Retinal fundus photograph · 45° FOV — 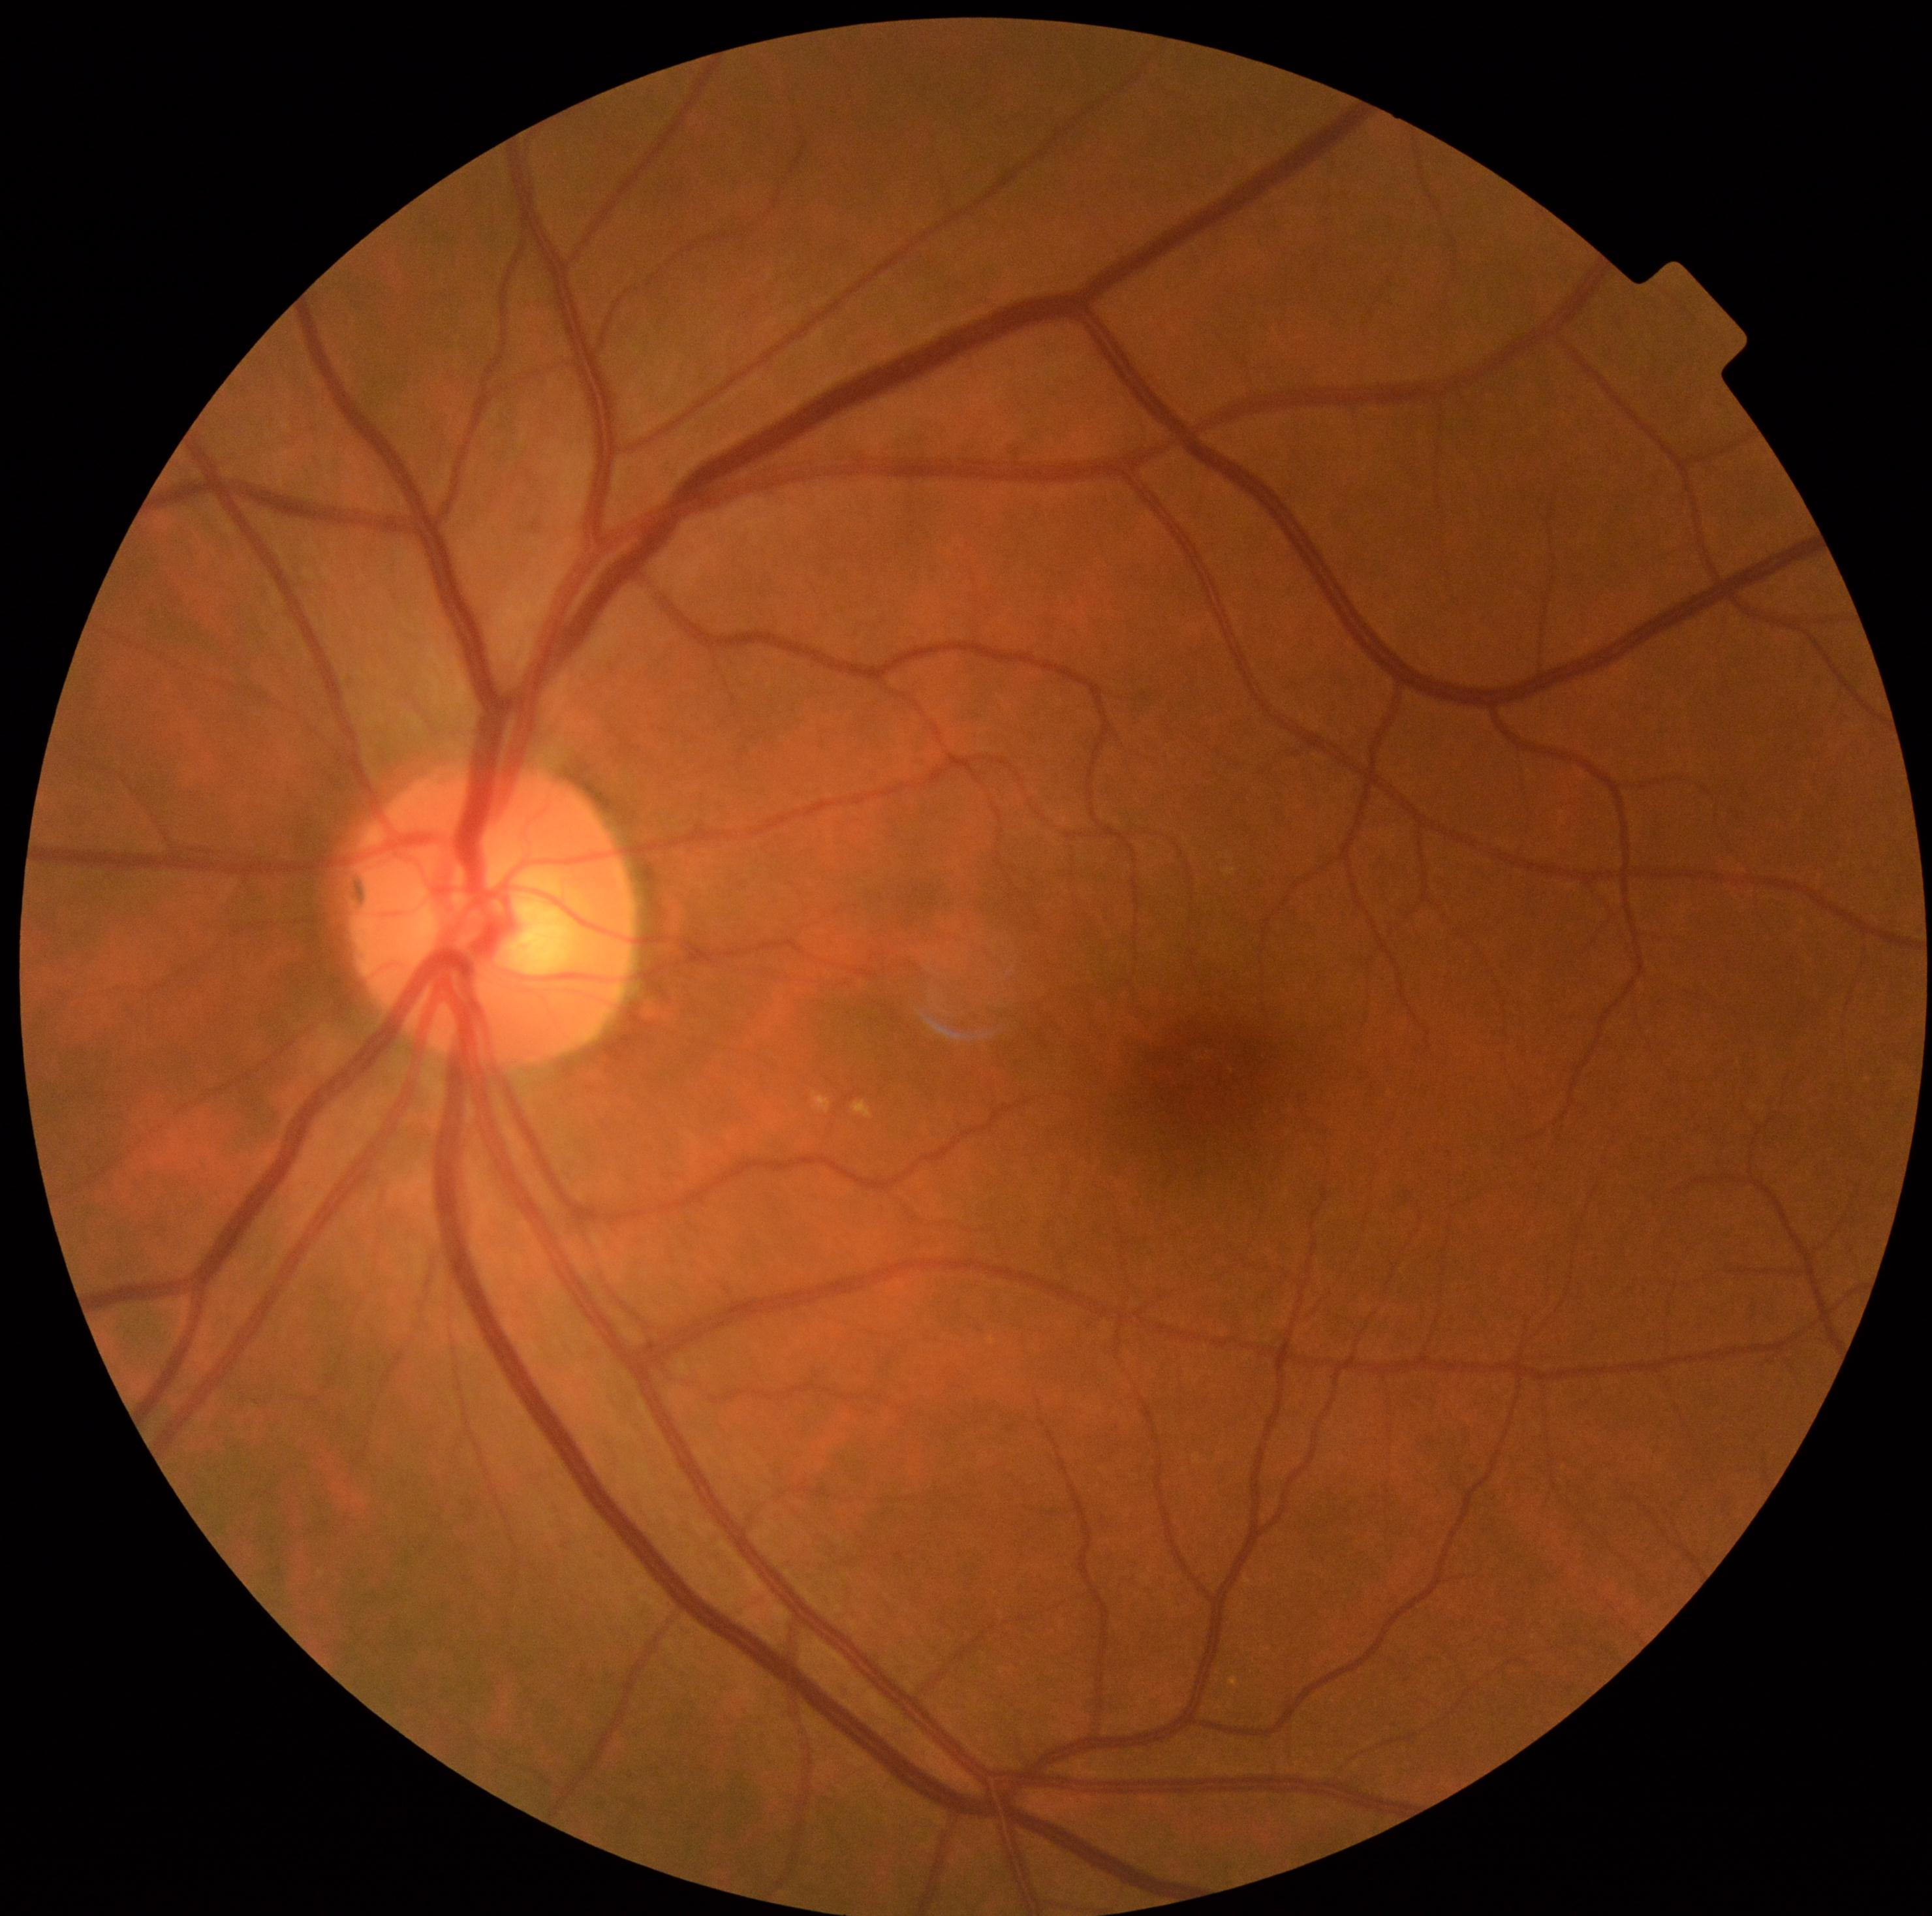

Diabetic retinopathy (DR) is 0/4.